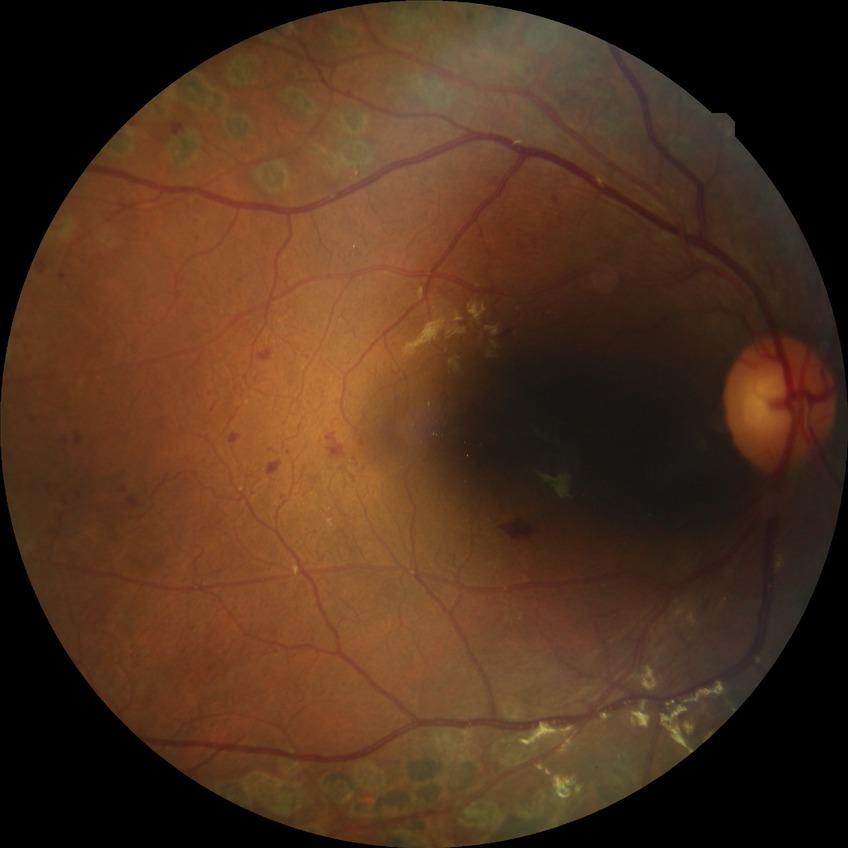
Diabetic retinopathy (DR) is proliferative diabetic retinopathy (PDR).